2352 by 1568 pixels: 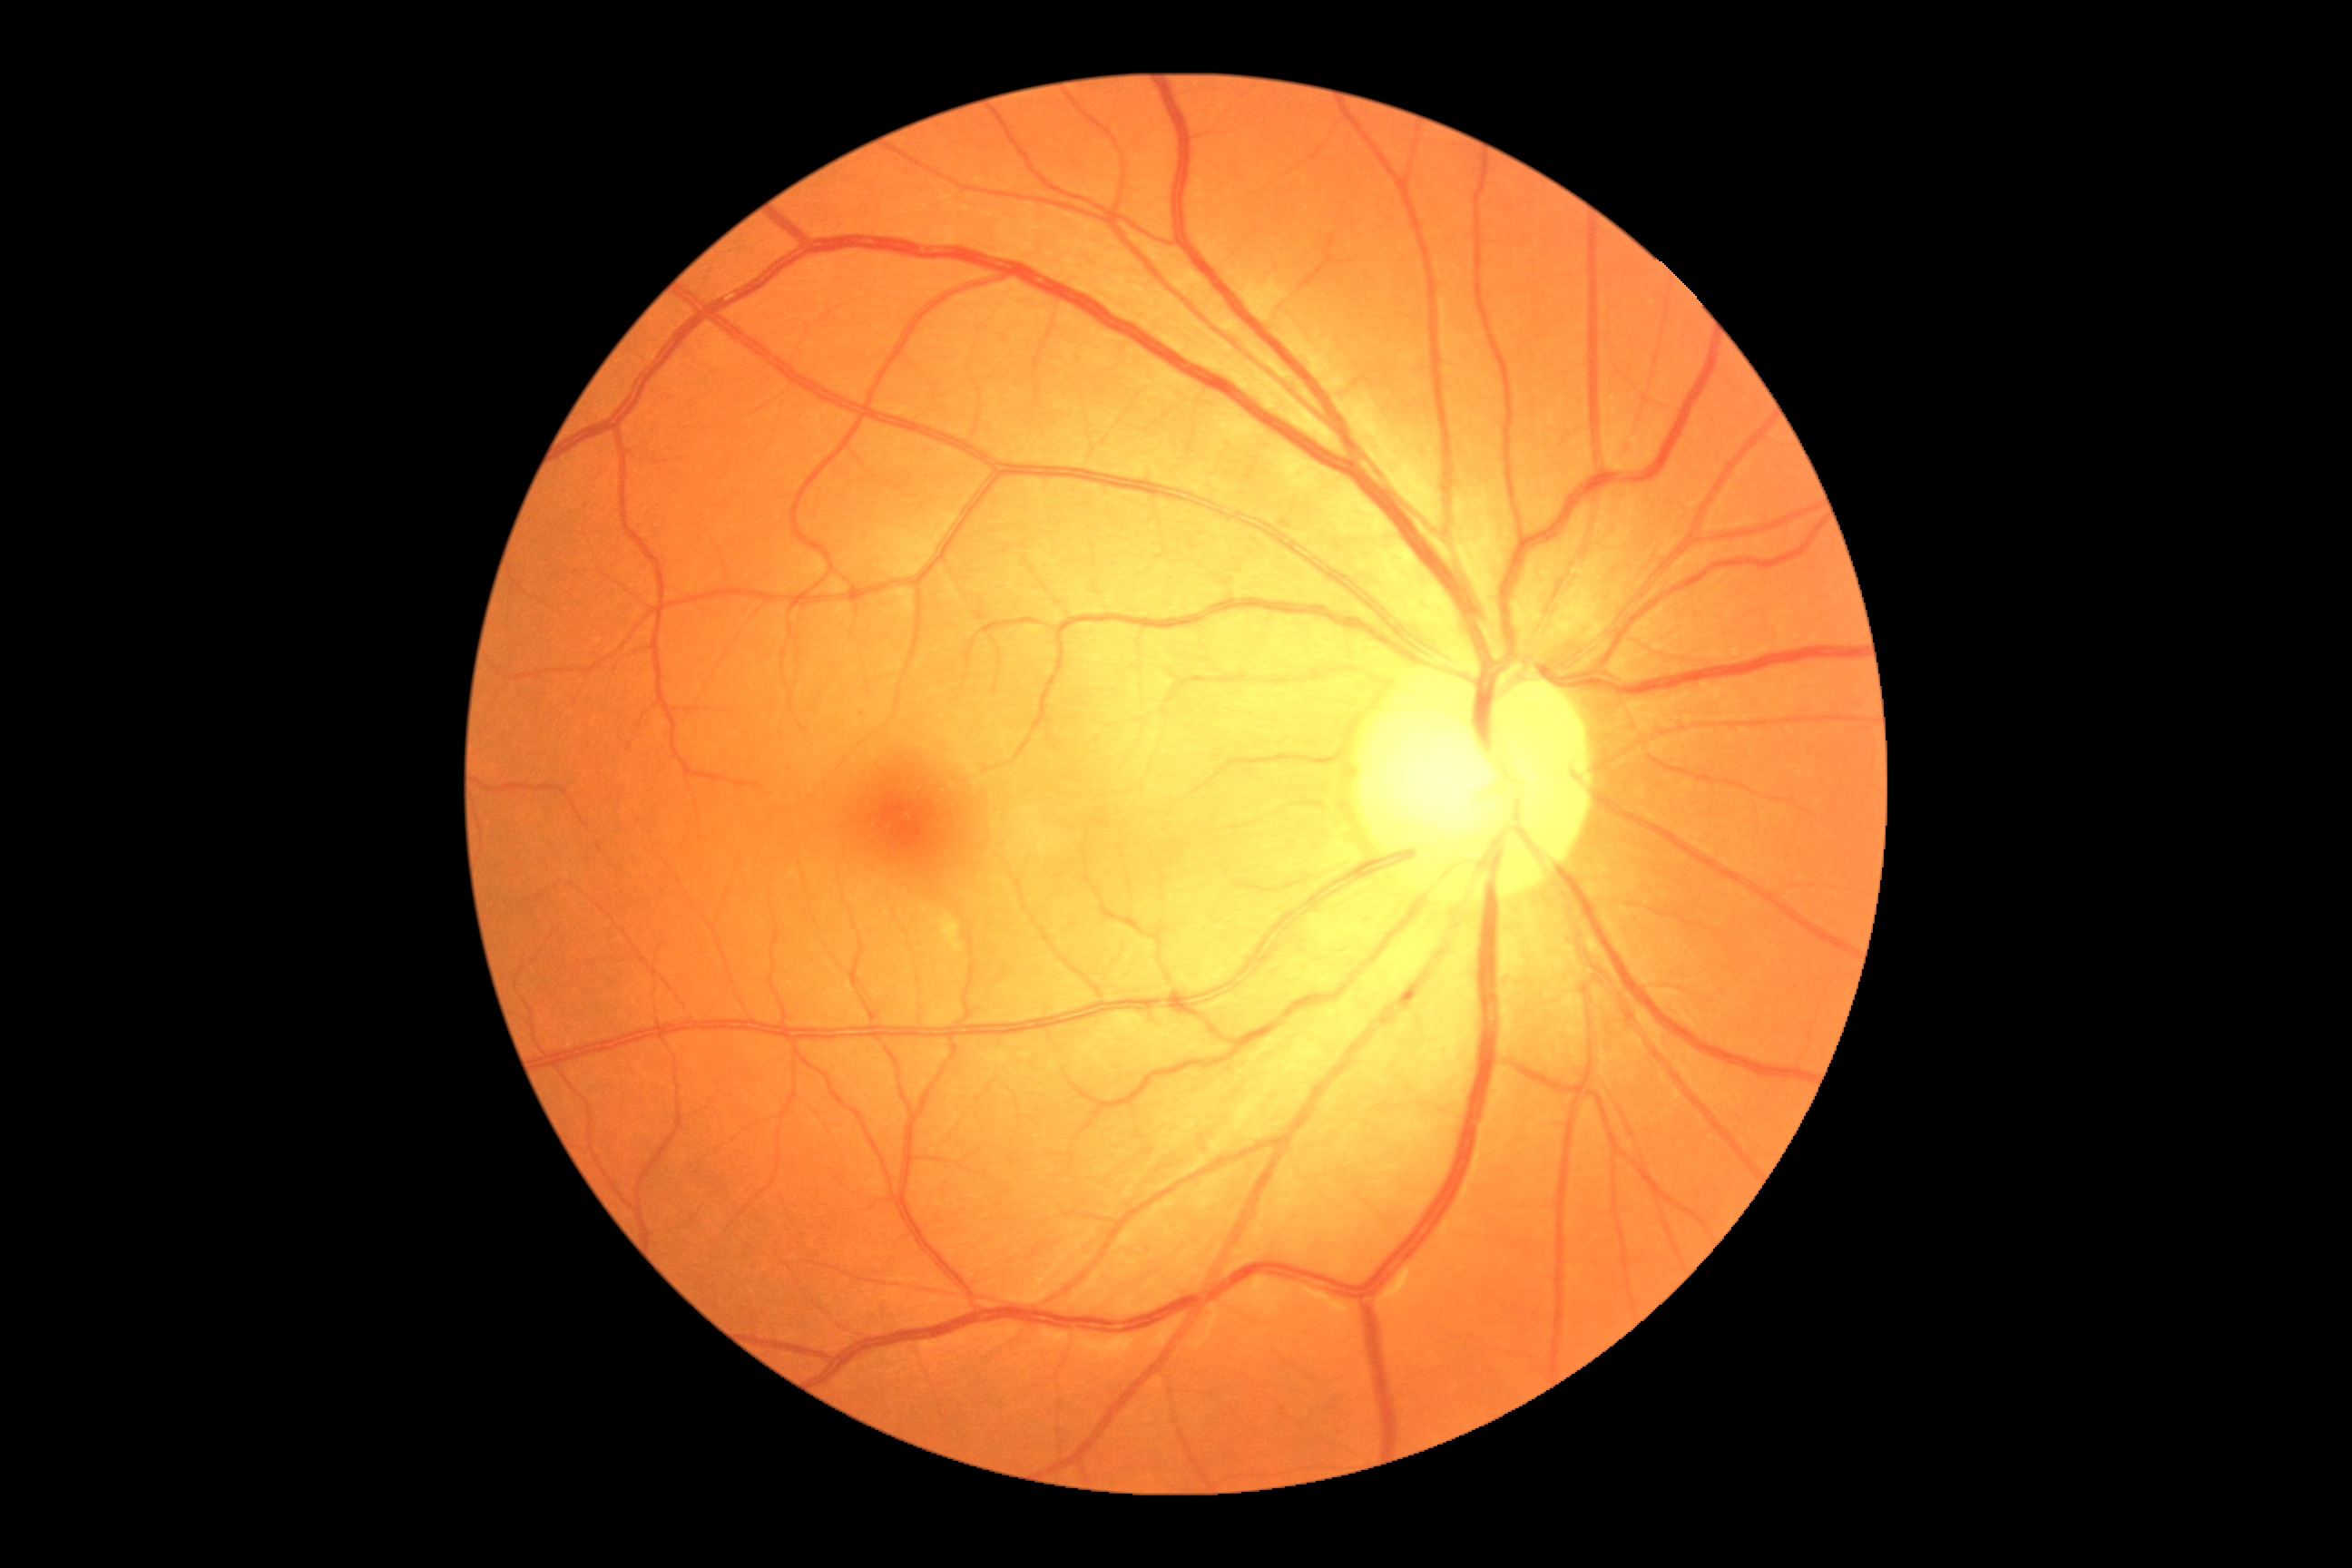

DR severity: grade 0 (no apparent retinopathy); DR impression: no DR findings.